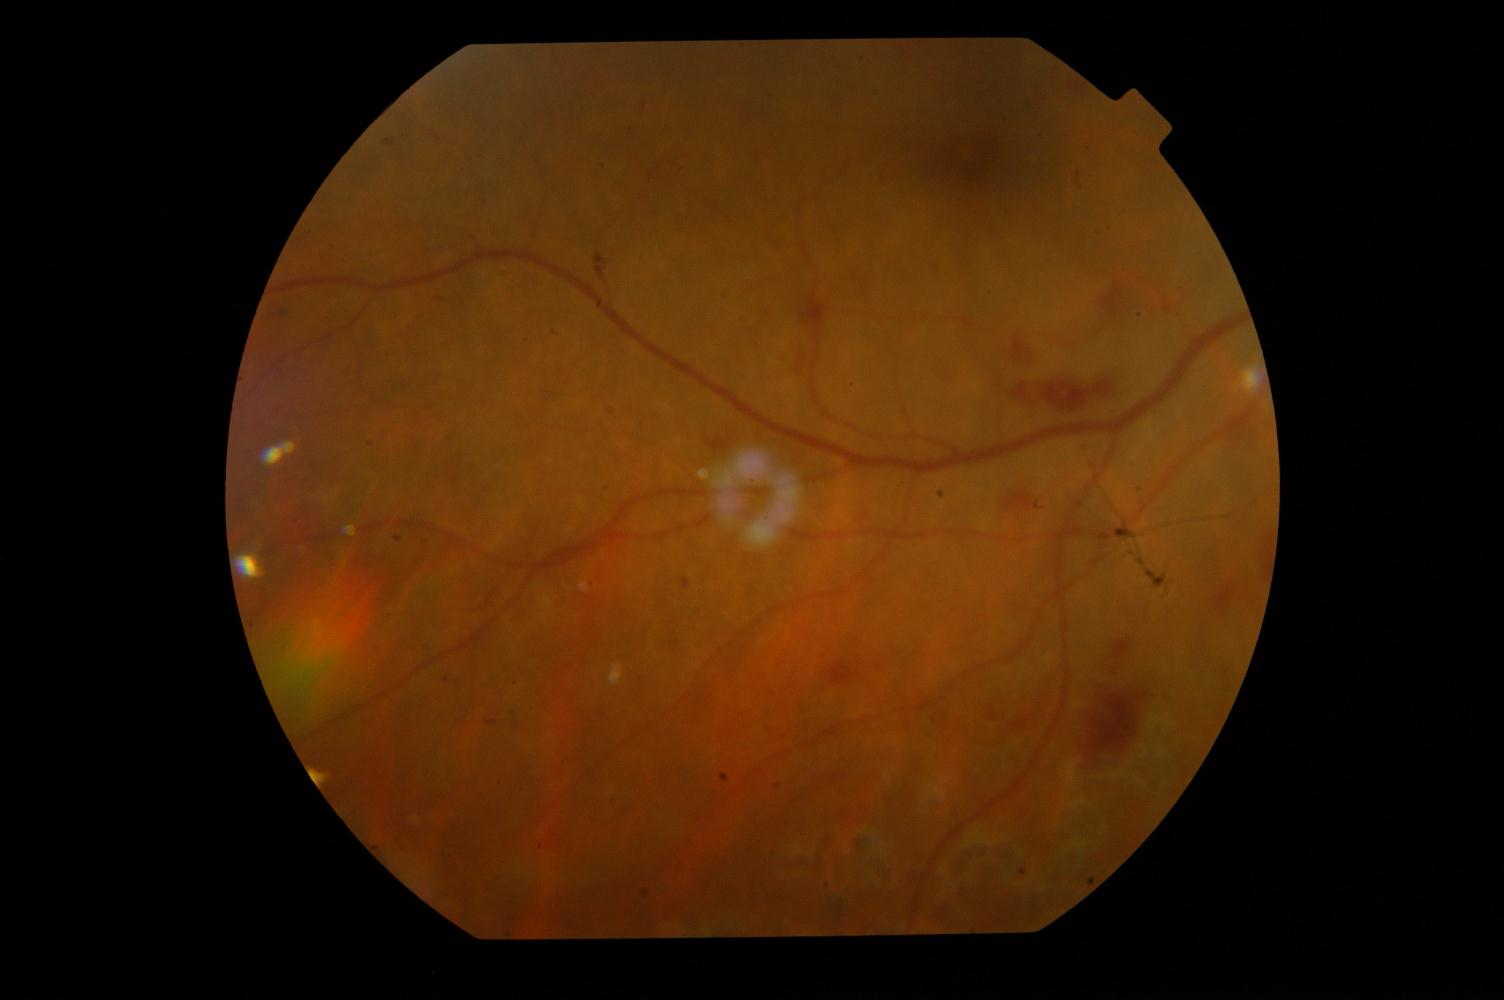 Diagnosis: DR (diabetic retinopathy).